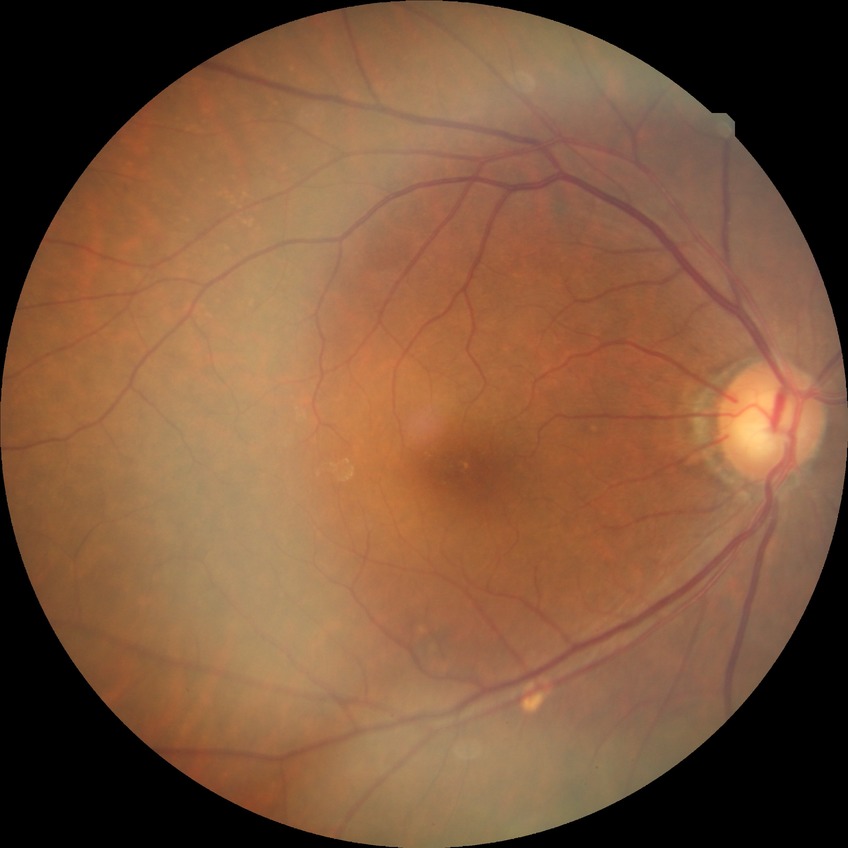
modified Davis classification@no diabetic retinopathy.